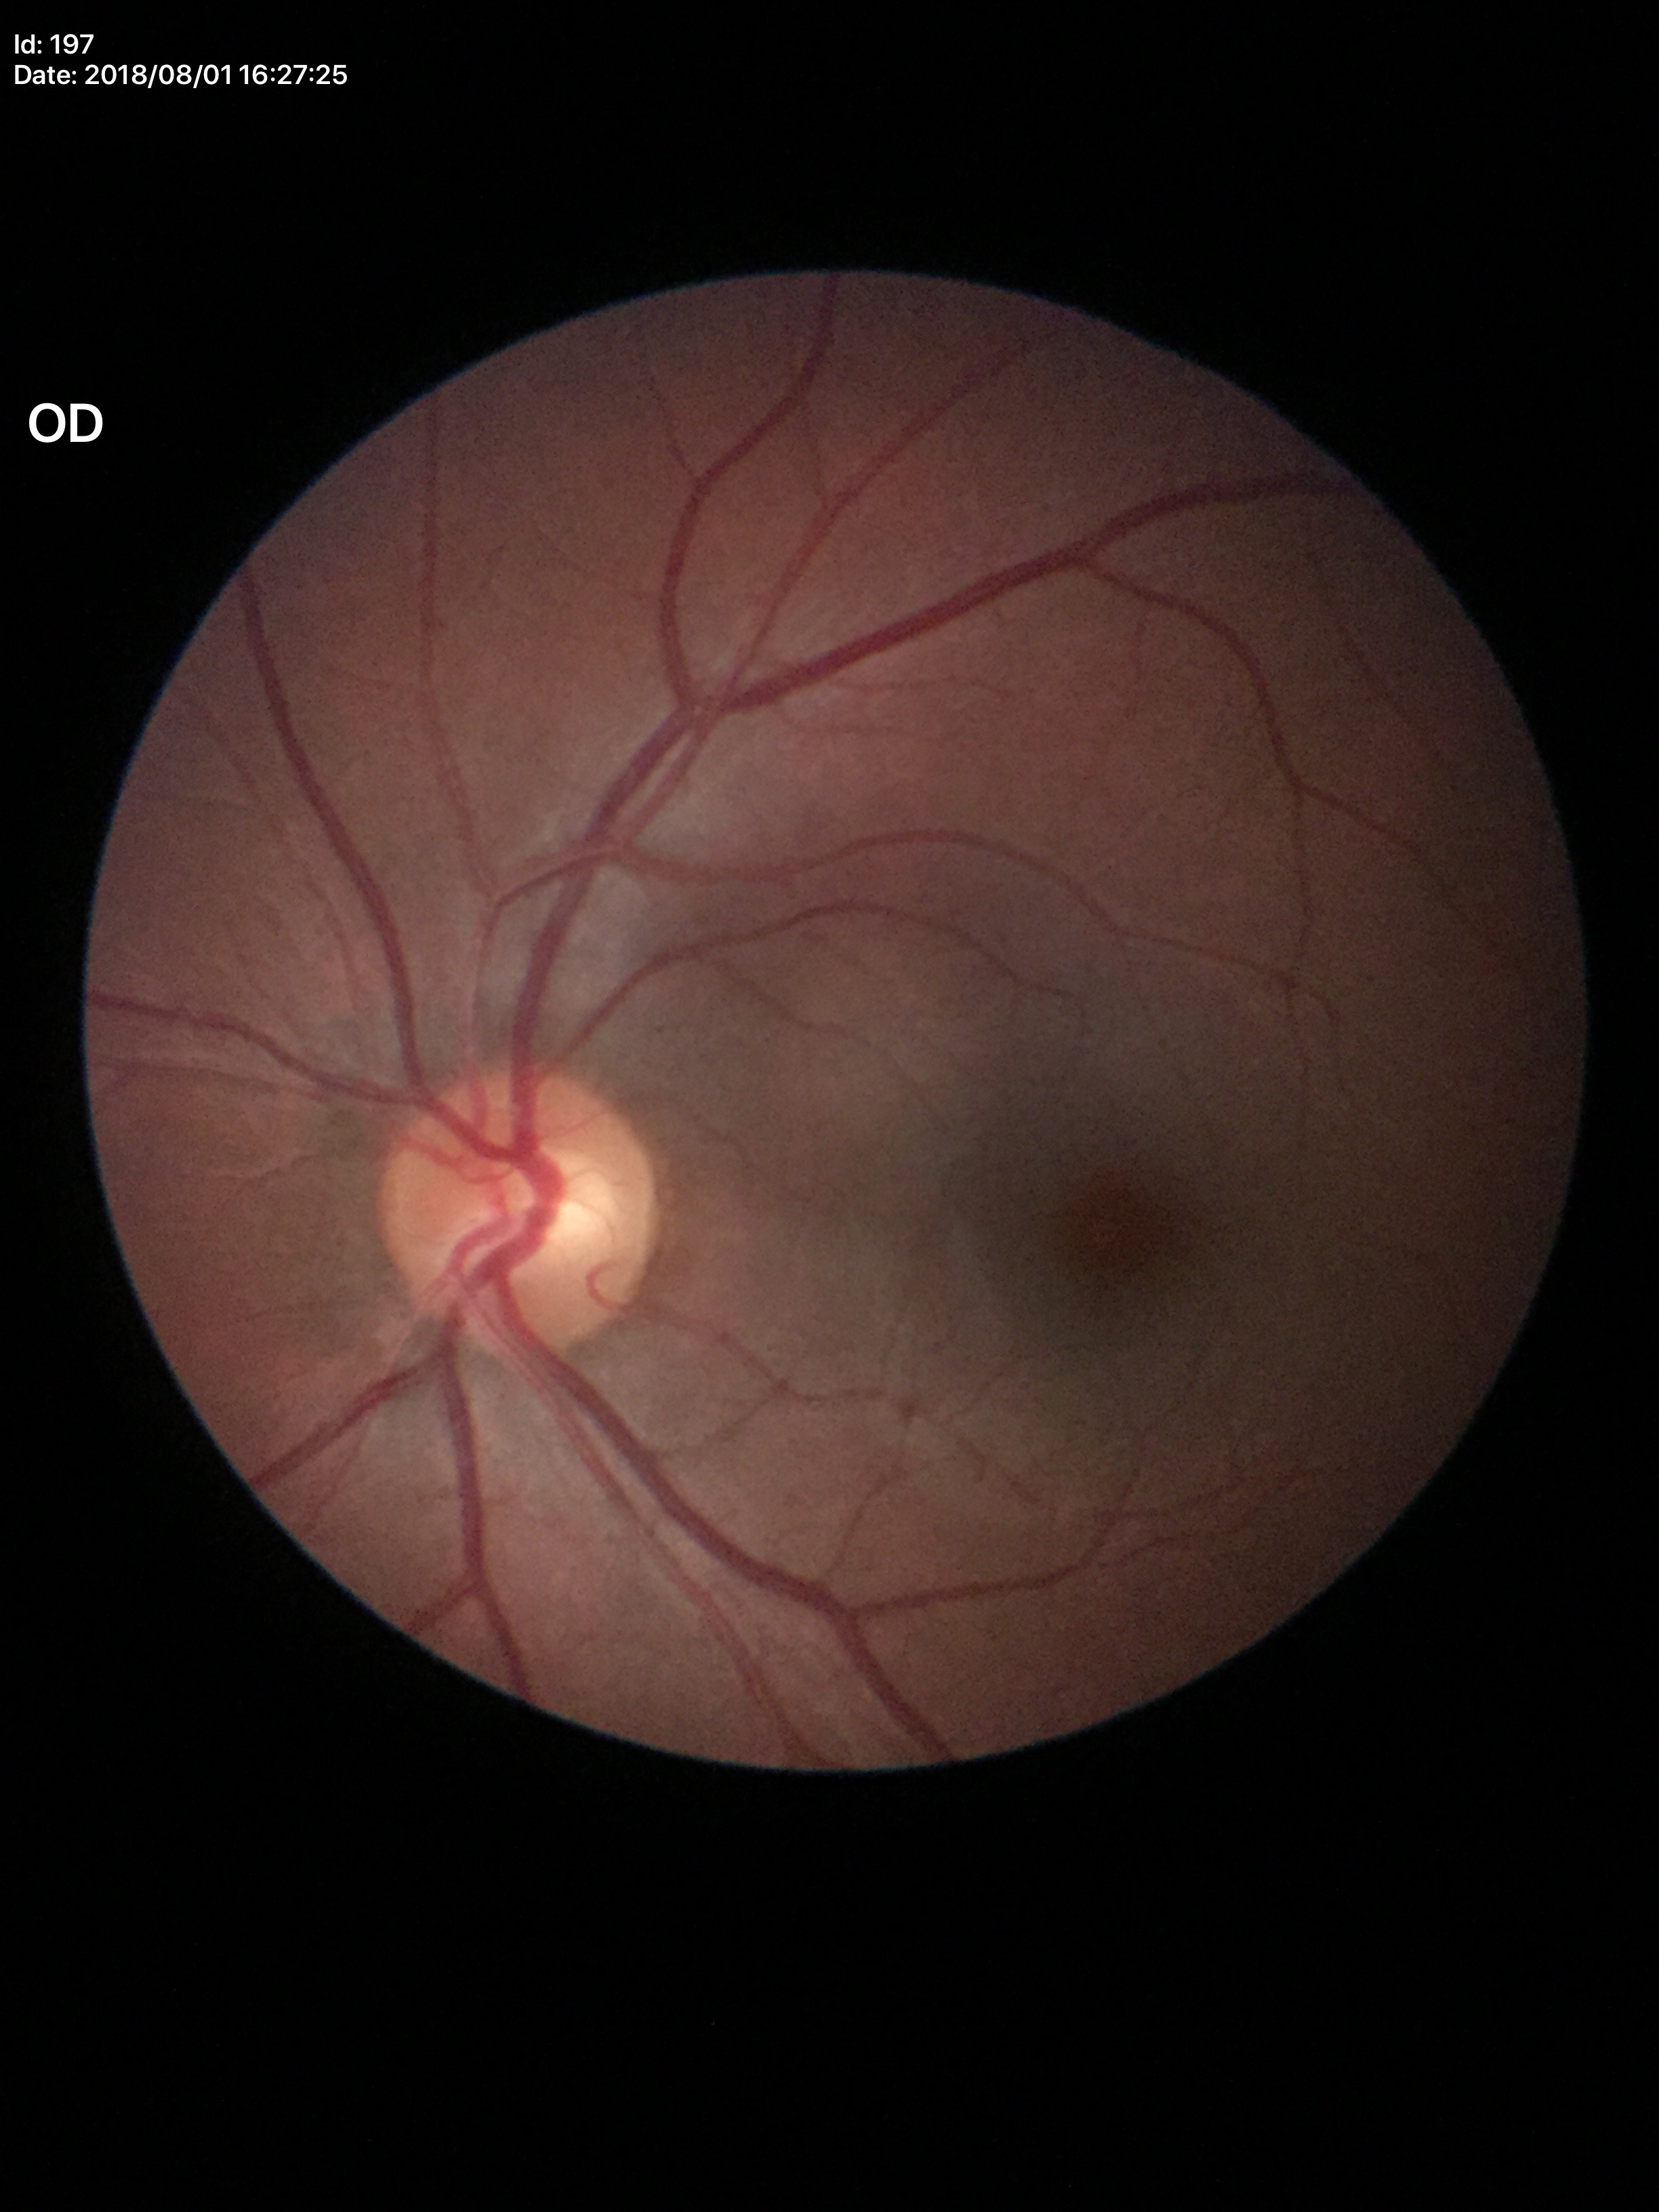

Q: Glaucoma screening result?
A: no suspicious findings (5/5 ophthalmologists in agreement)
Q: What is the VCDR?
A: 0.58